Graded on the modified Davis scale, without pupil dilation — 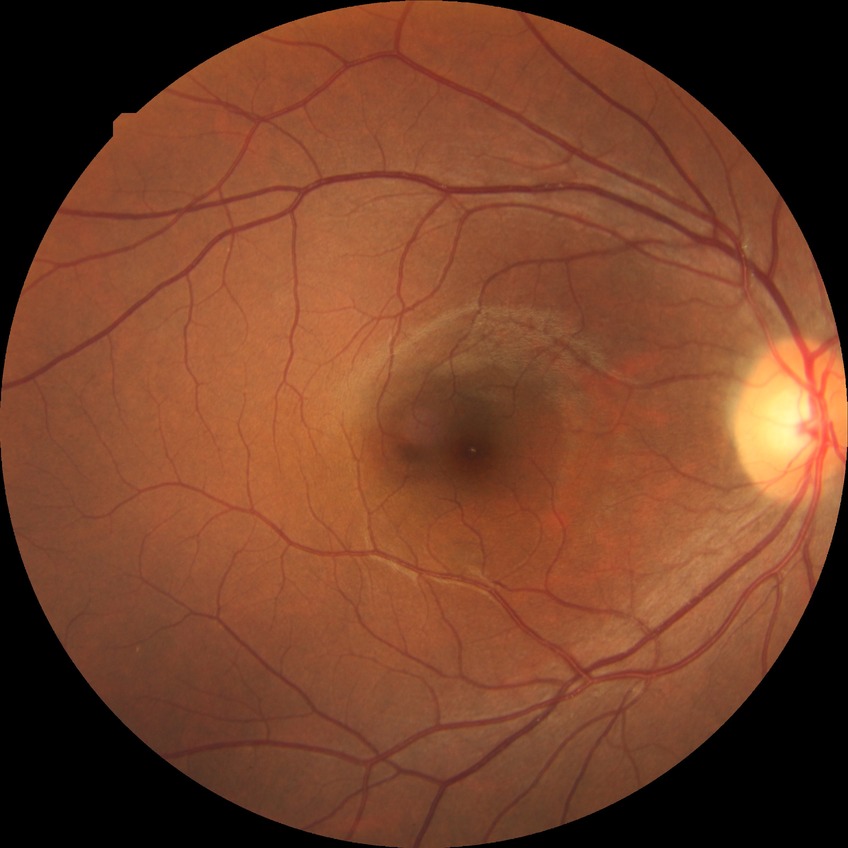 diabetic retinopathy (DR): NDR (no diabetic retinopathy)